1659x2212: 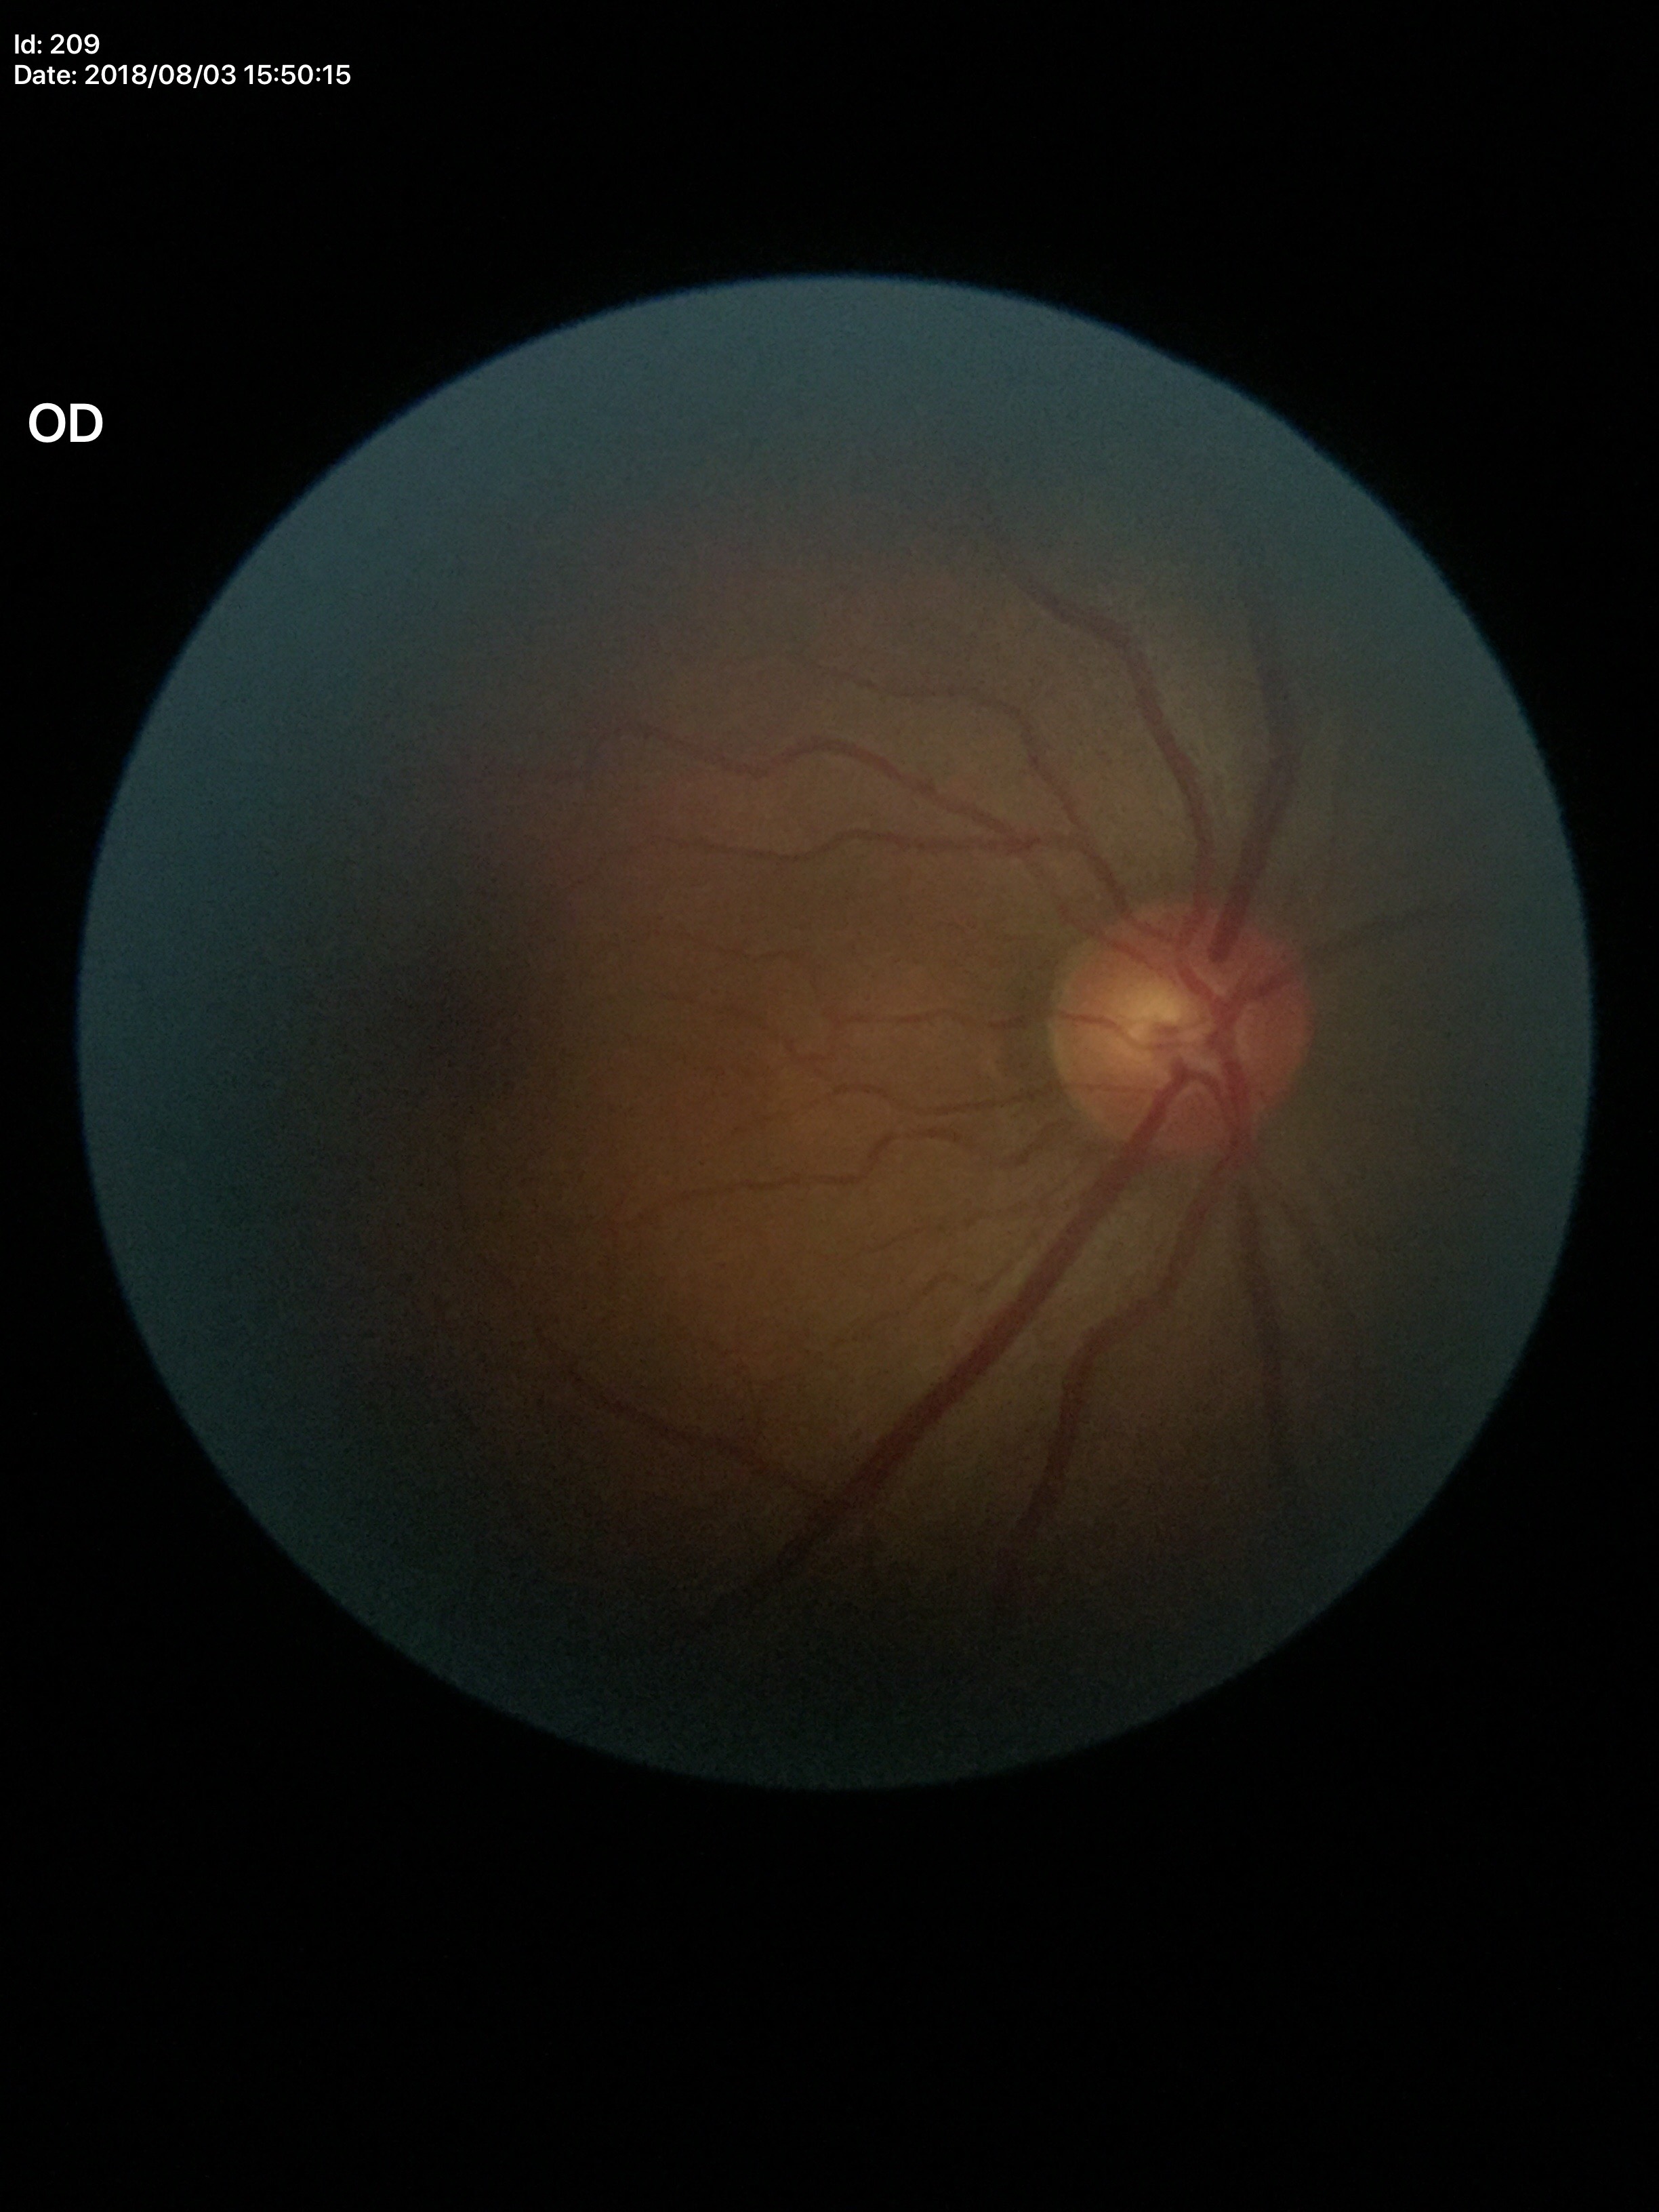 {"glaucoma_decision": "negative", "vcdr": "0.51"}